45-degree field of view. Fundus photo. 1932x1916px.
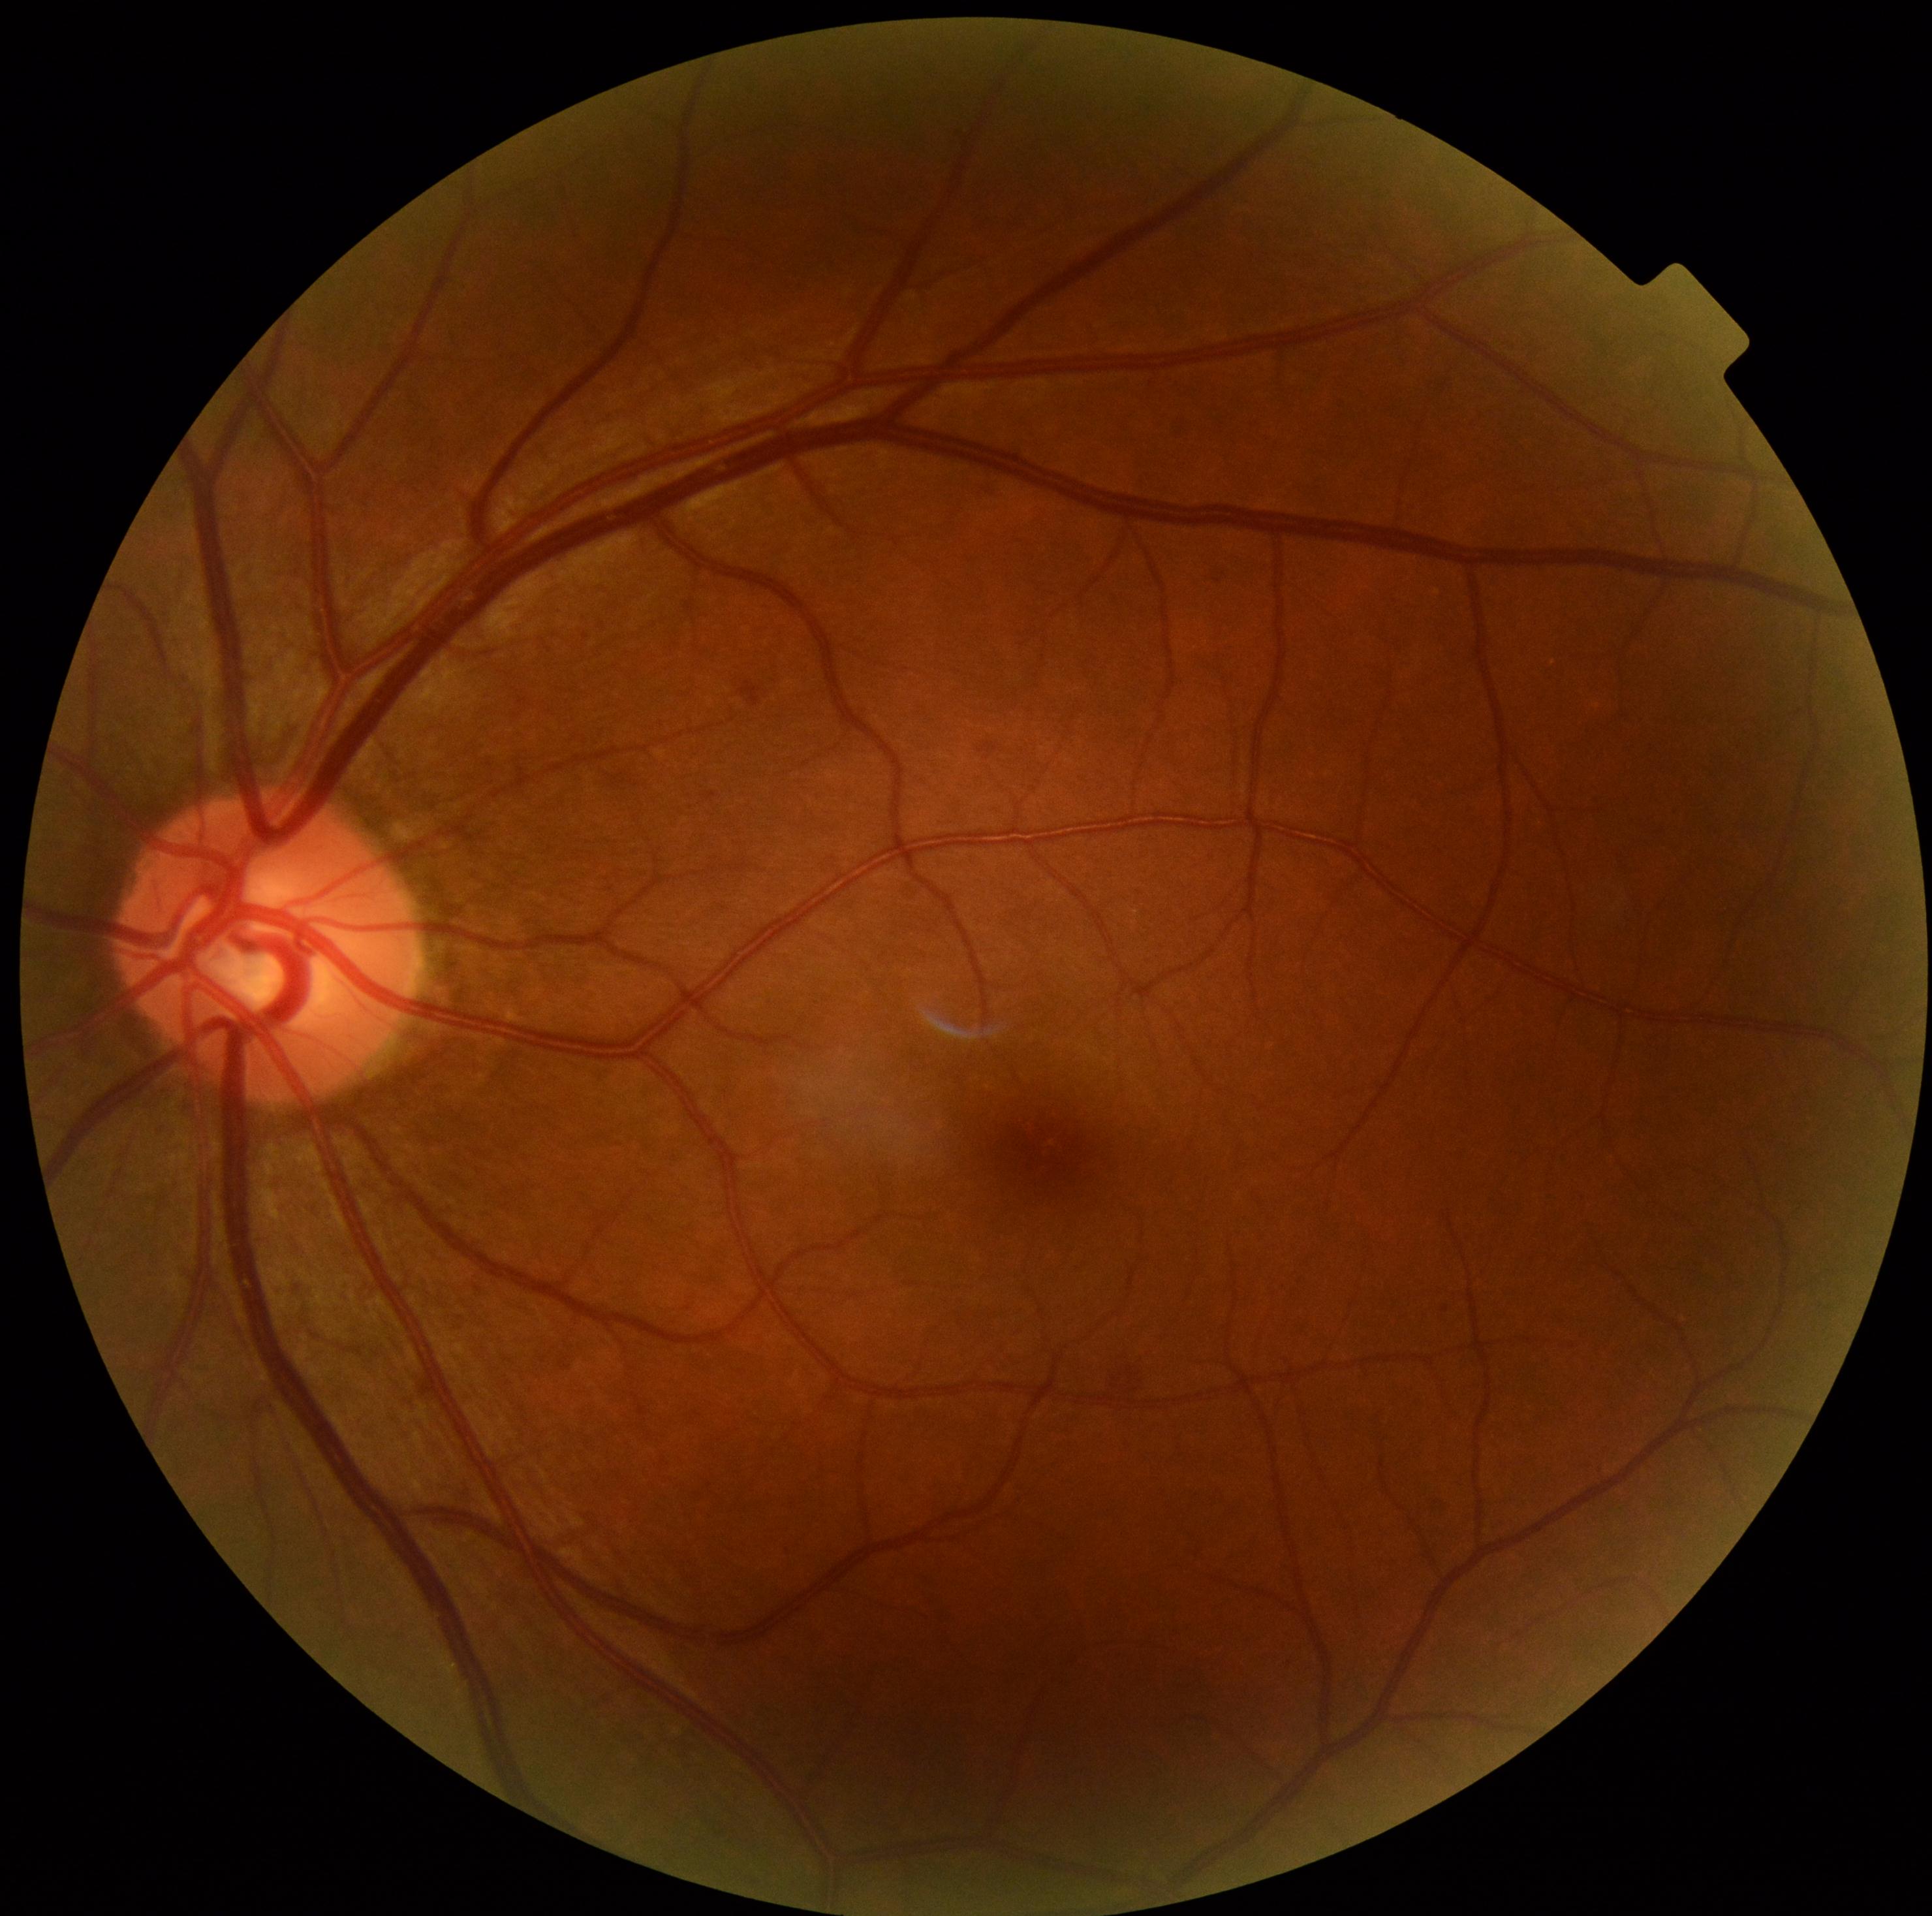
DR class=non-proliferative diabetic retinopathy, DR severity=grade 2 (moderate NPDR).